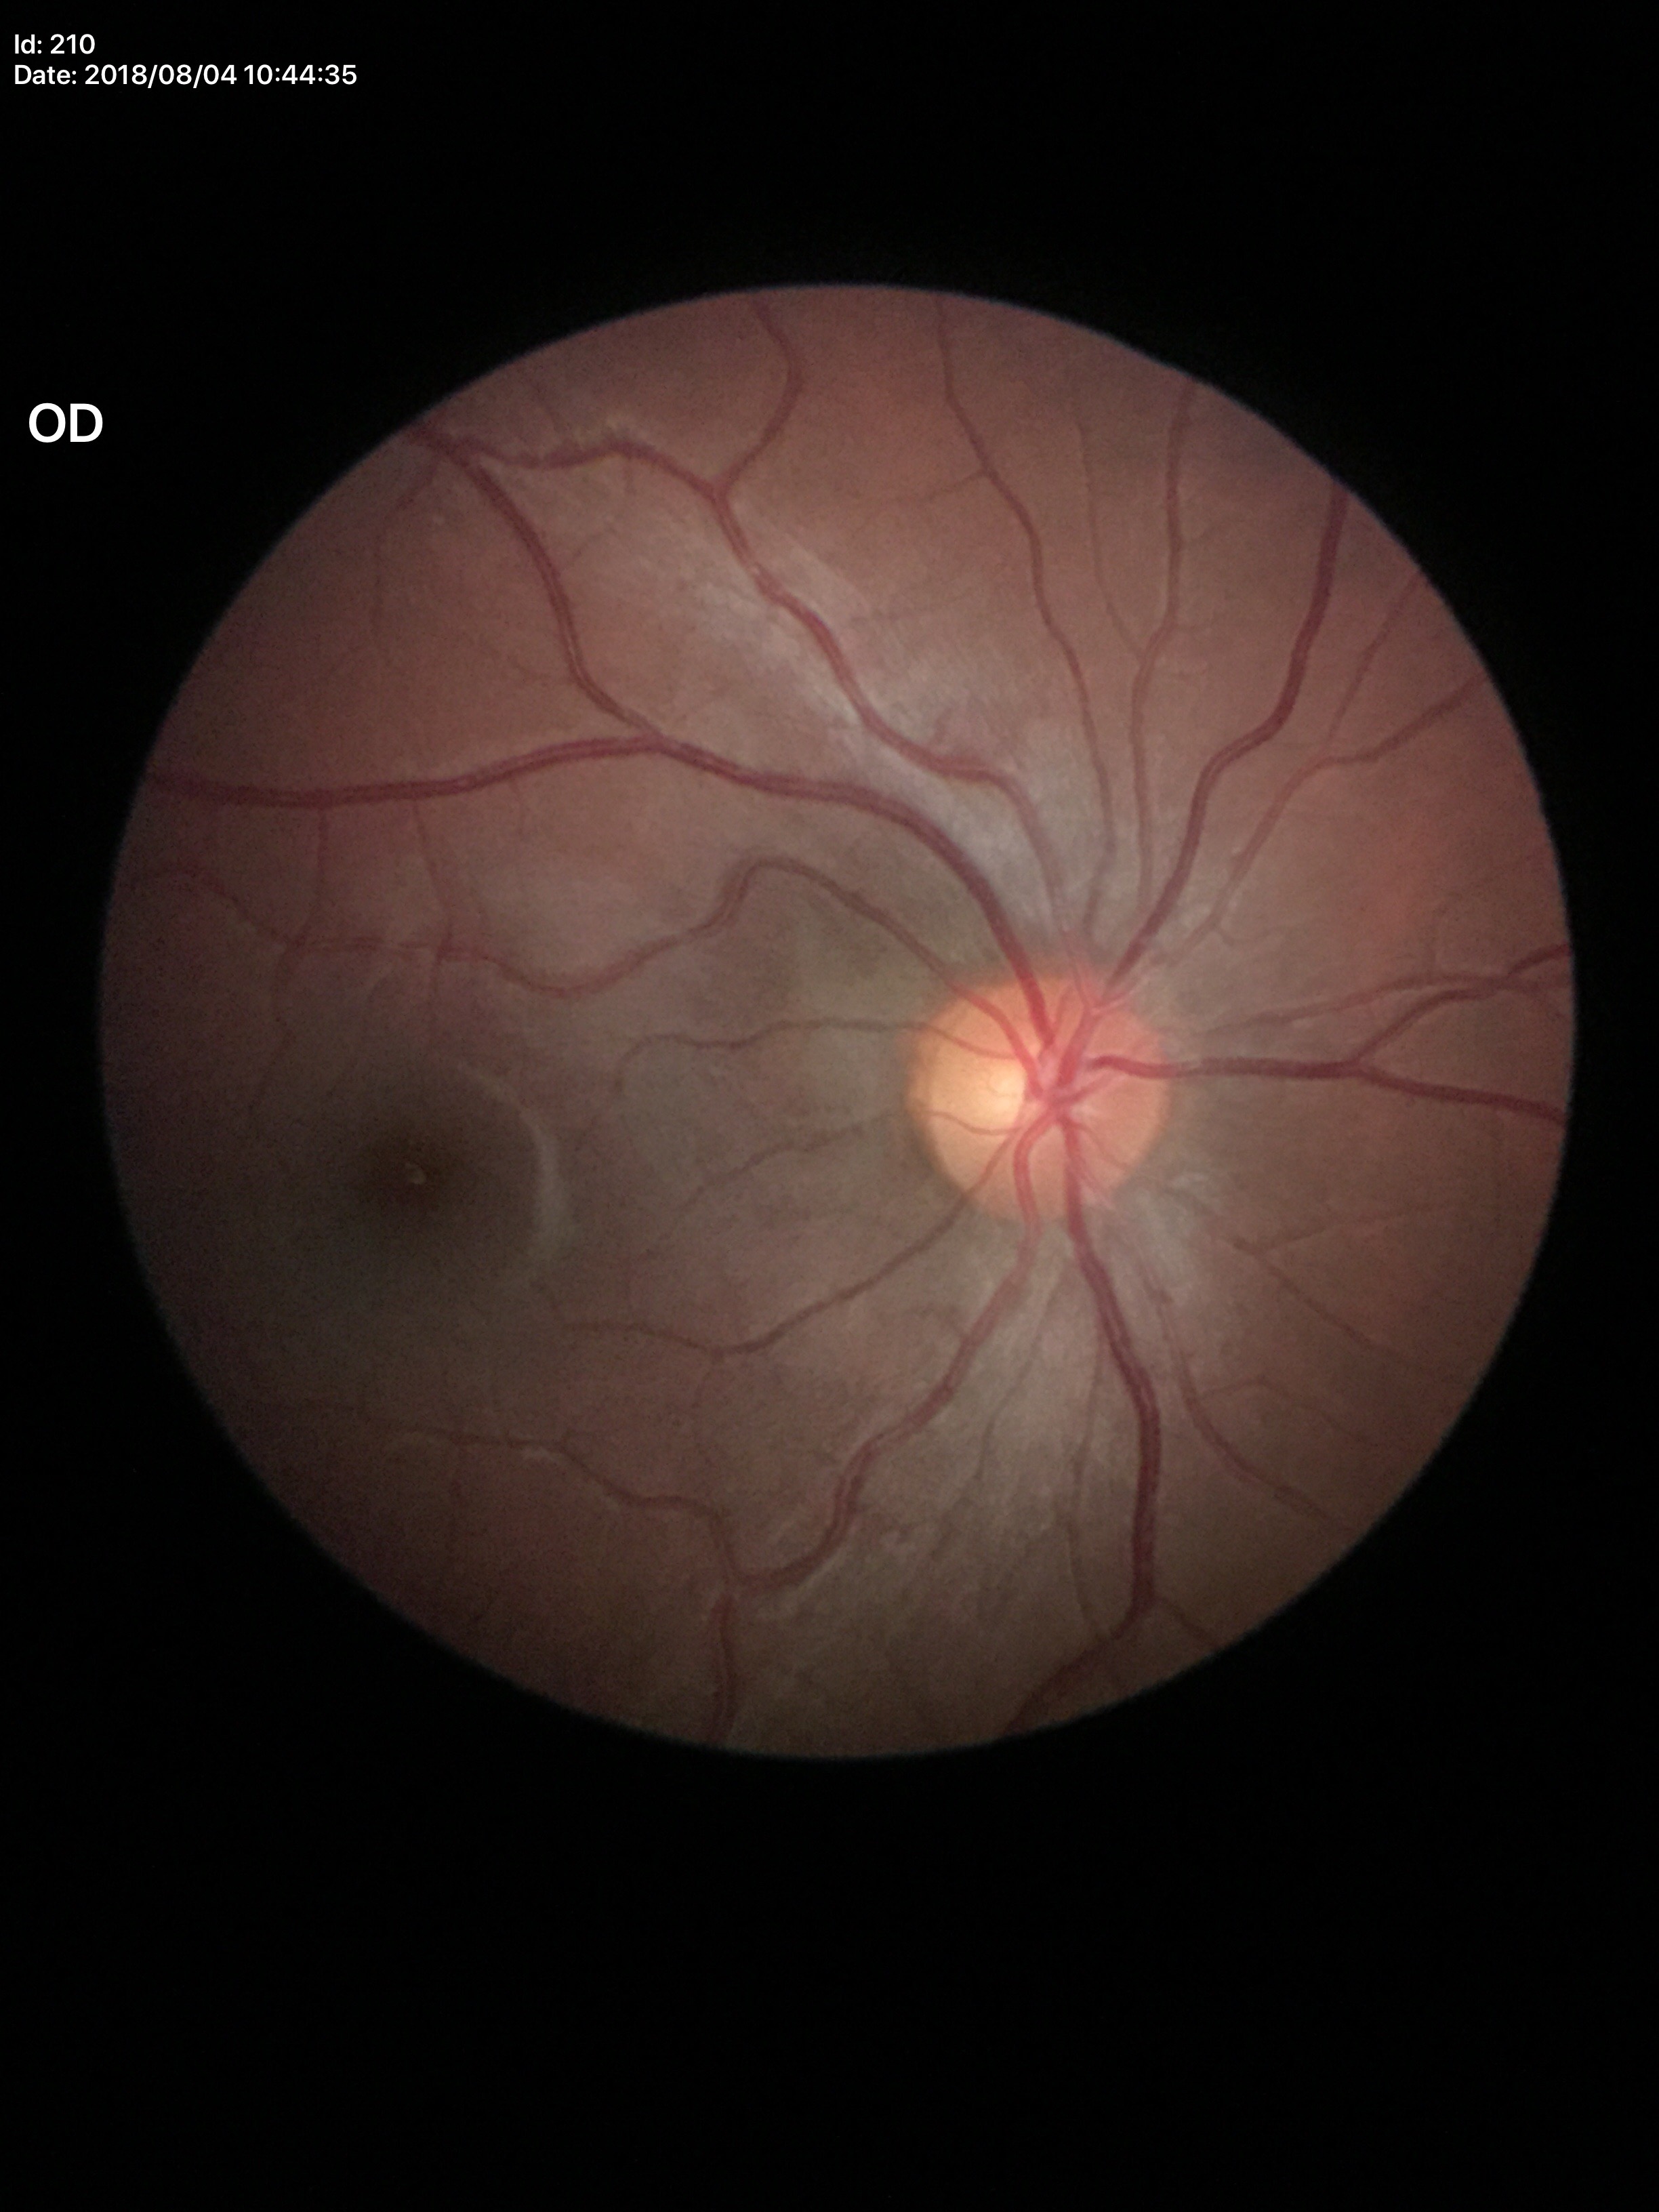 vertical CDR (VCDR)=0.45 | area cup-to-disc ratio (ACDR)=0.21 | Glaucoma evaluation=negative (unanimous normal call)